Pupil-dilated.
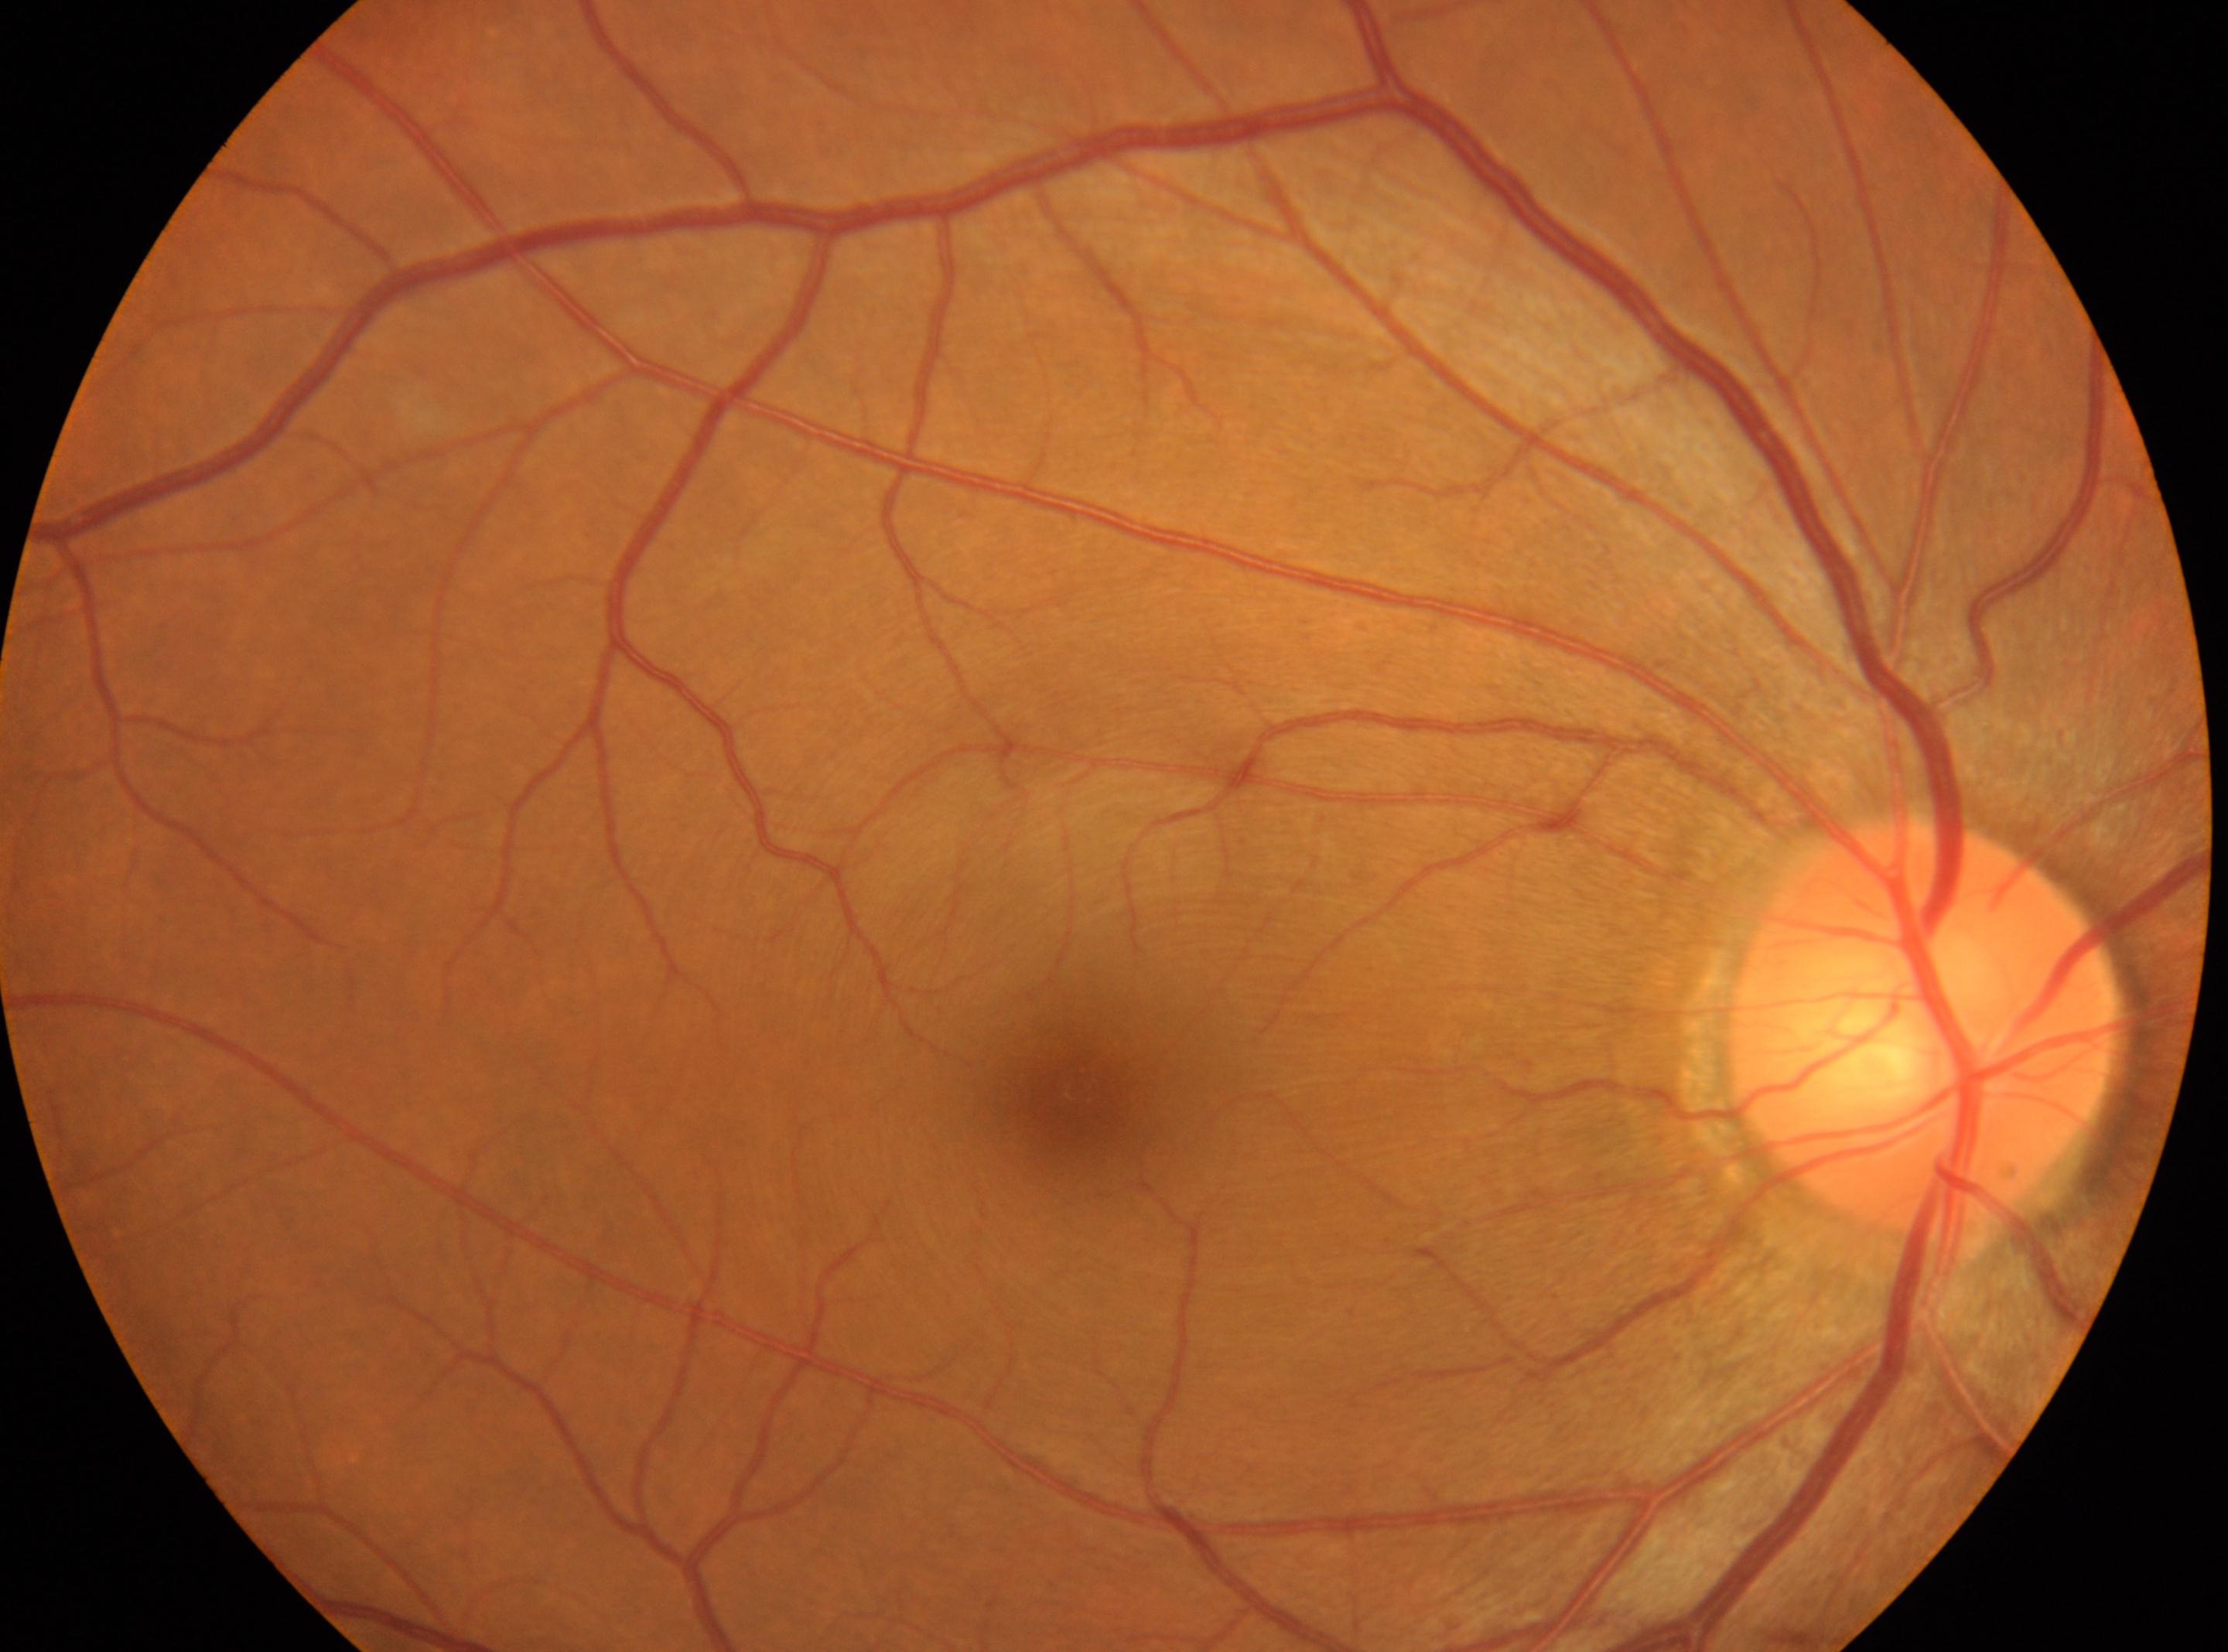
optic disk: [1925, 1029], the fovea: [1077, 1091], eye: OD, DR: 0/4.